Image size 1240x1240 · wide-field fundus photograph of an infant:
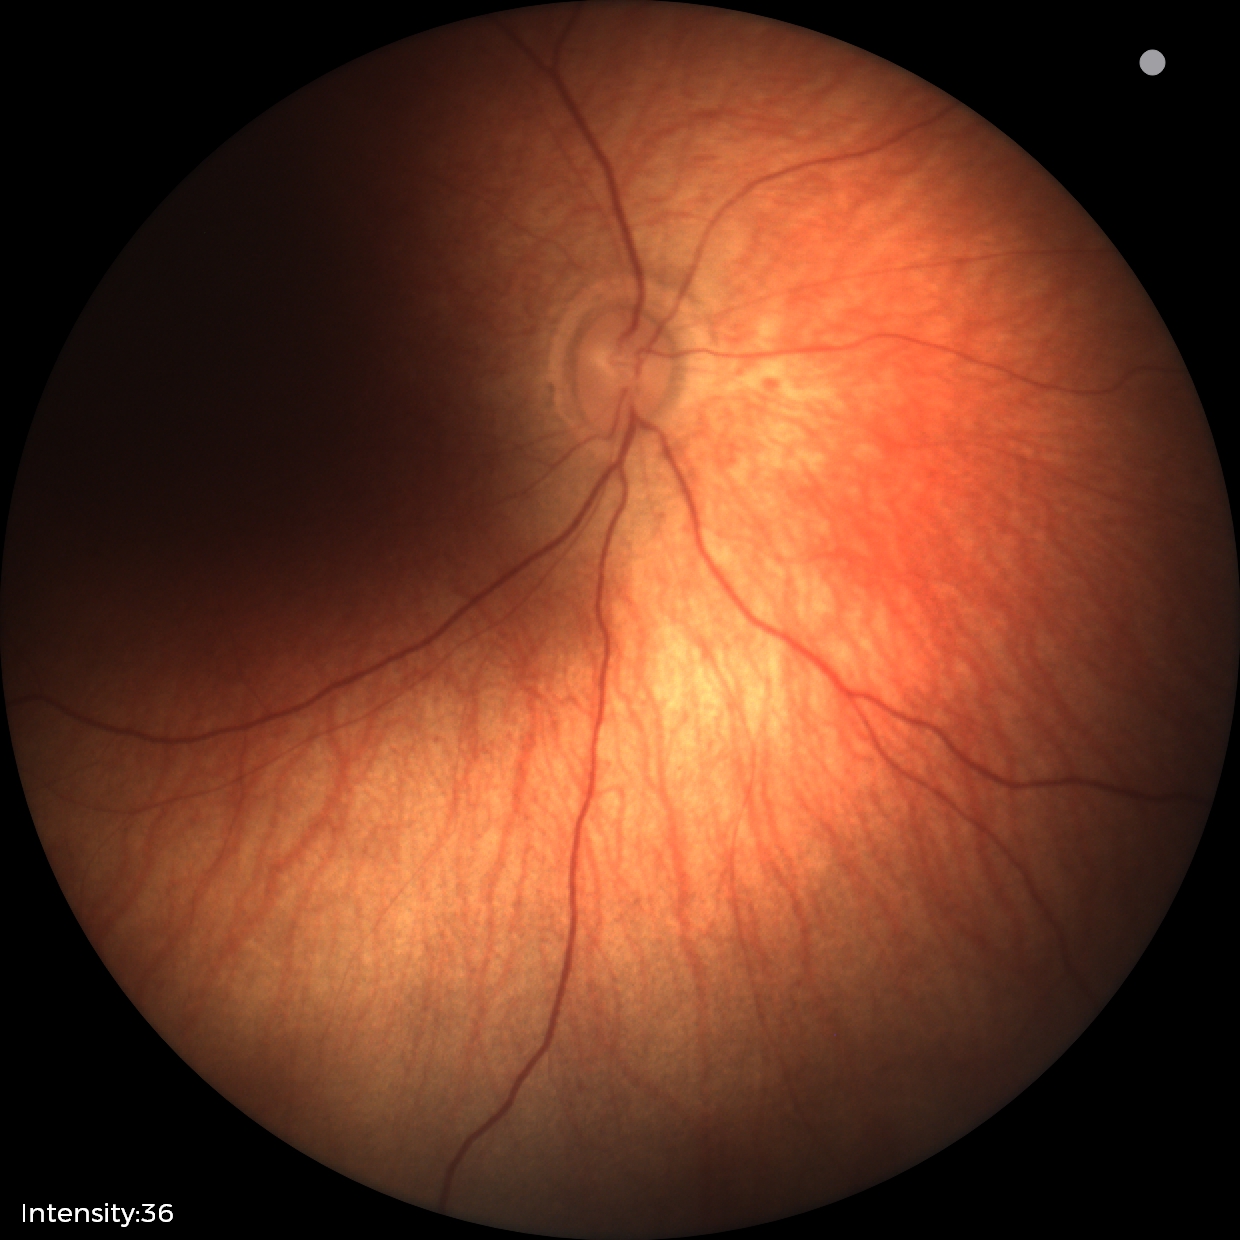

Assessment: physiological appearance with no retinal pathology.